45-degree field of view; retinal fundus photograph: 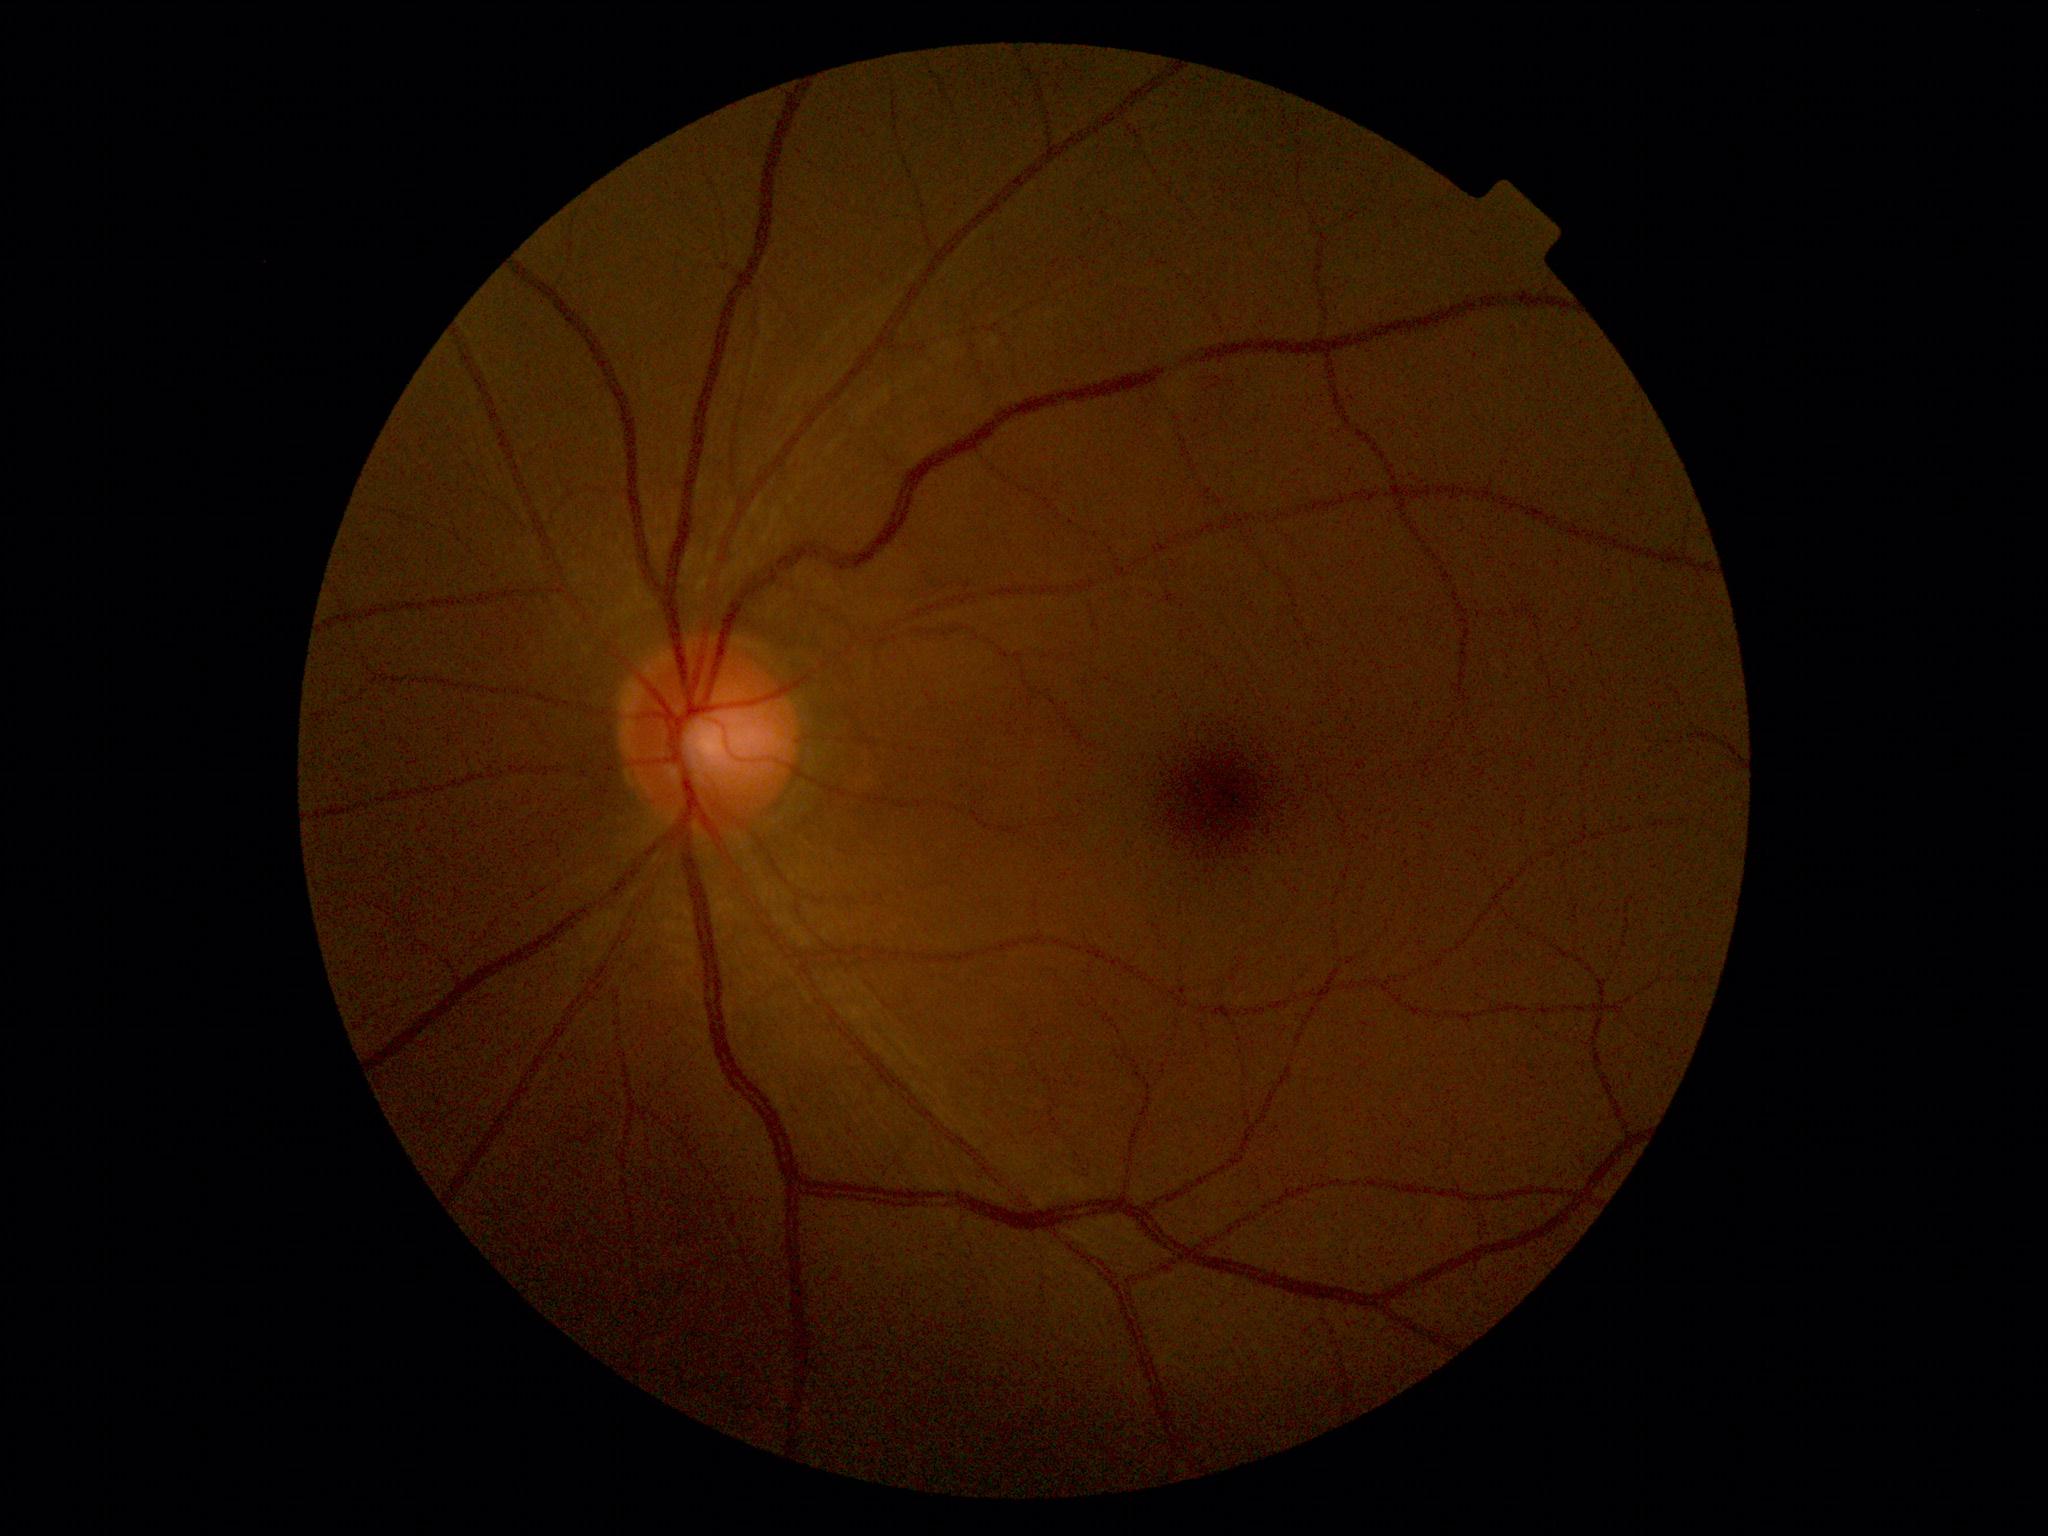

diabetic retinopathy (DR) = no apparent diabetic retinopathy (grade 0); DR impression = negative for DR.